Davis DR grading.
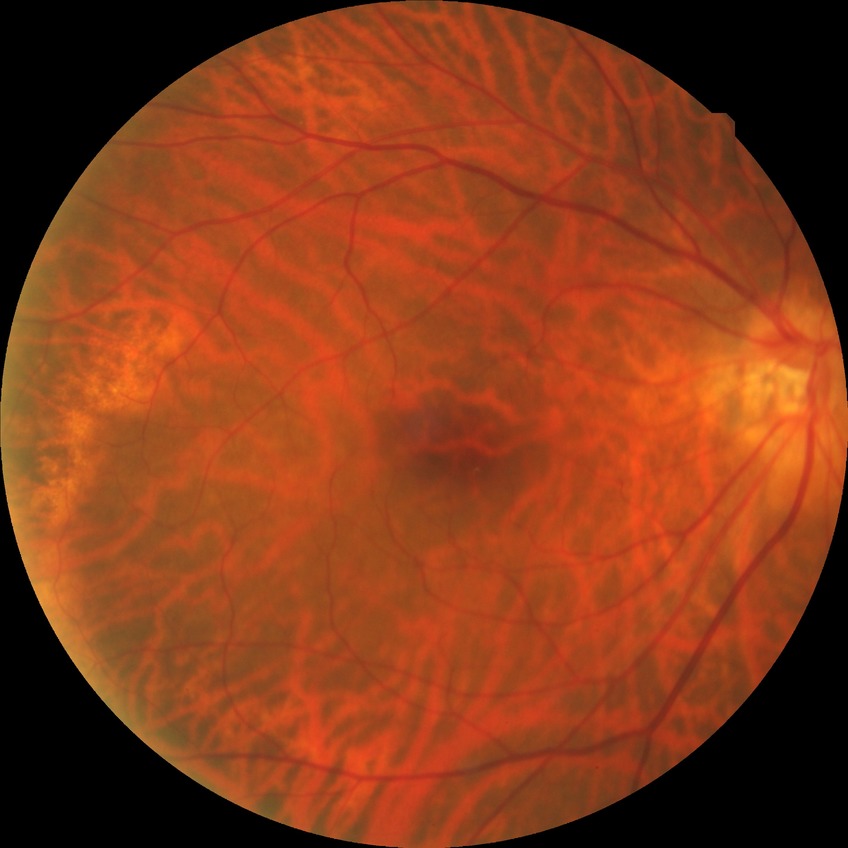
Diabetic retinopathy severity is no diabetic retinopathy.